Davis DR grading: 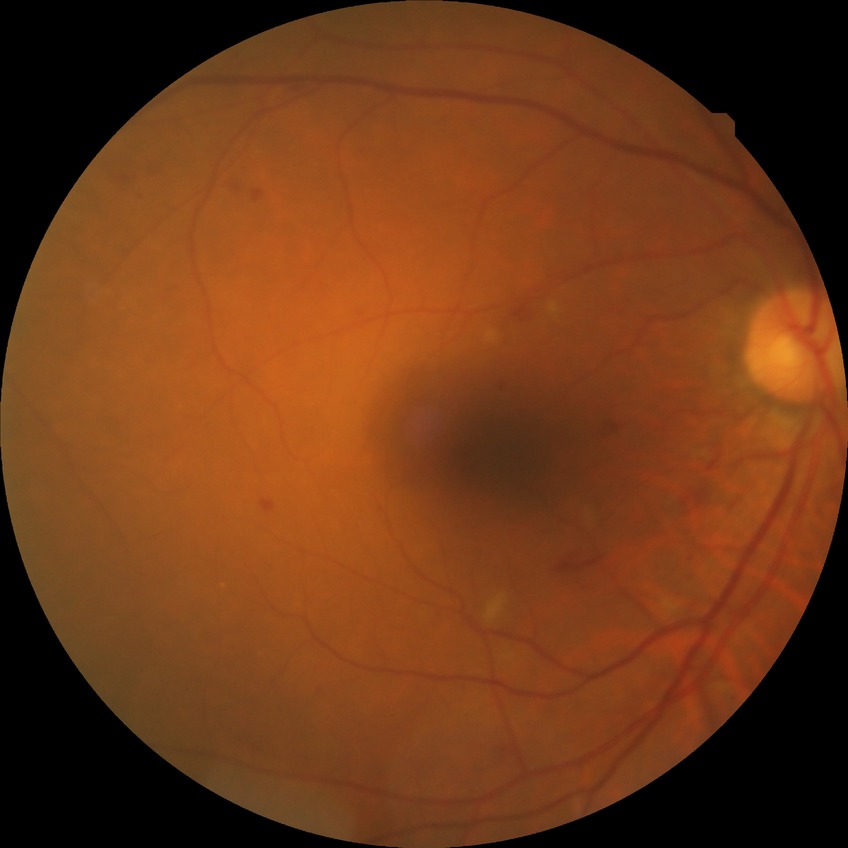

Disease class: non-proliferative diabetic retinopathy. DR grade: SDR.